2352 by 1568 pixels.
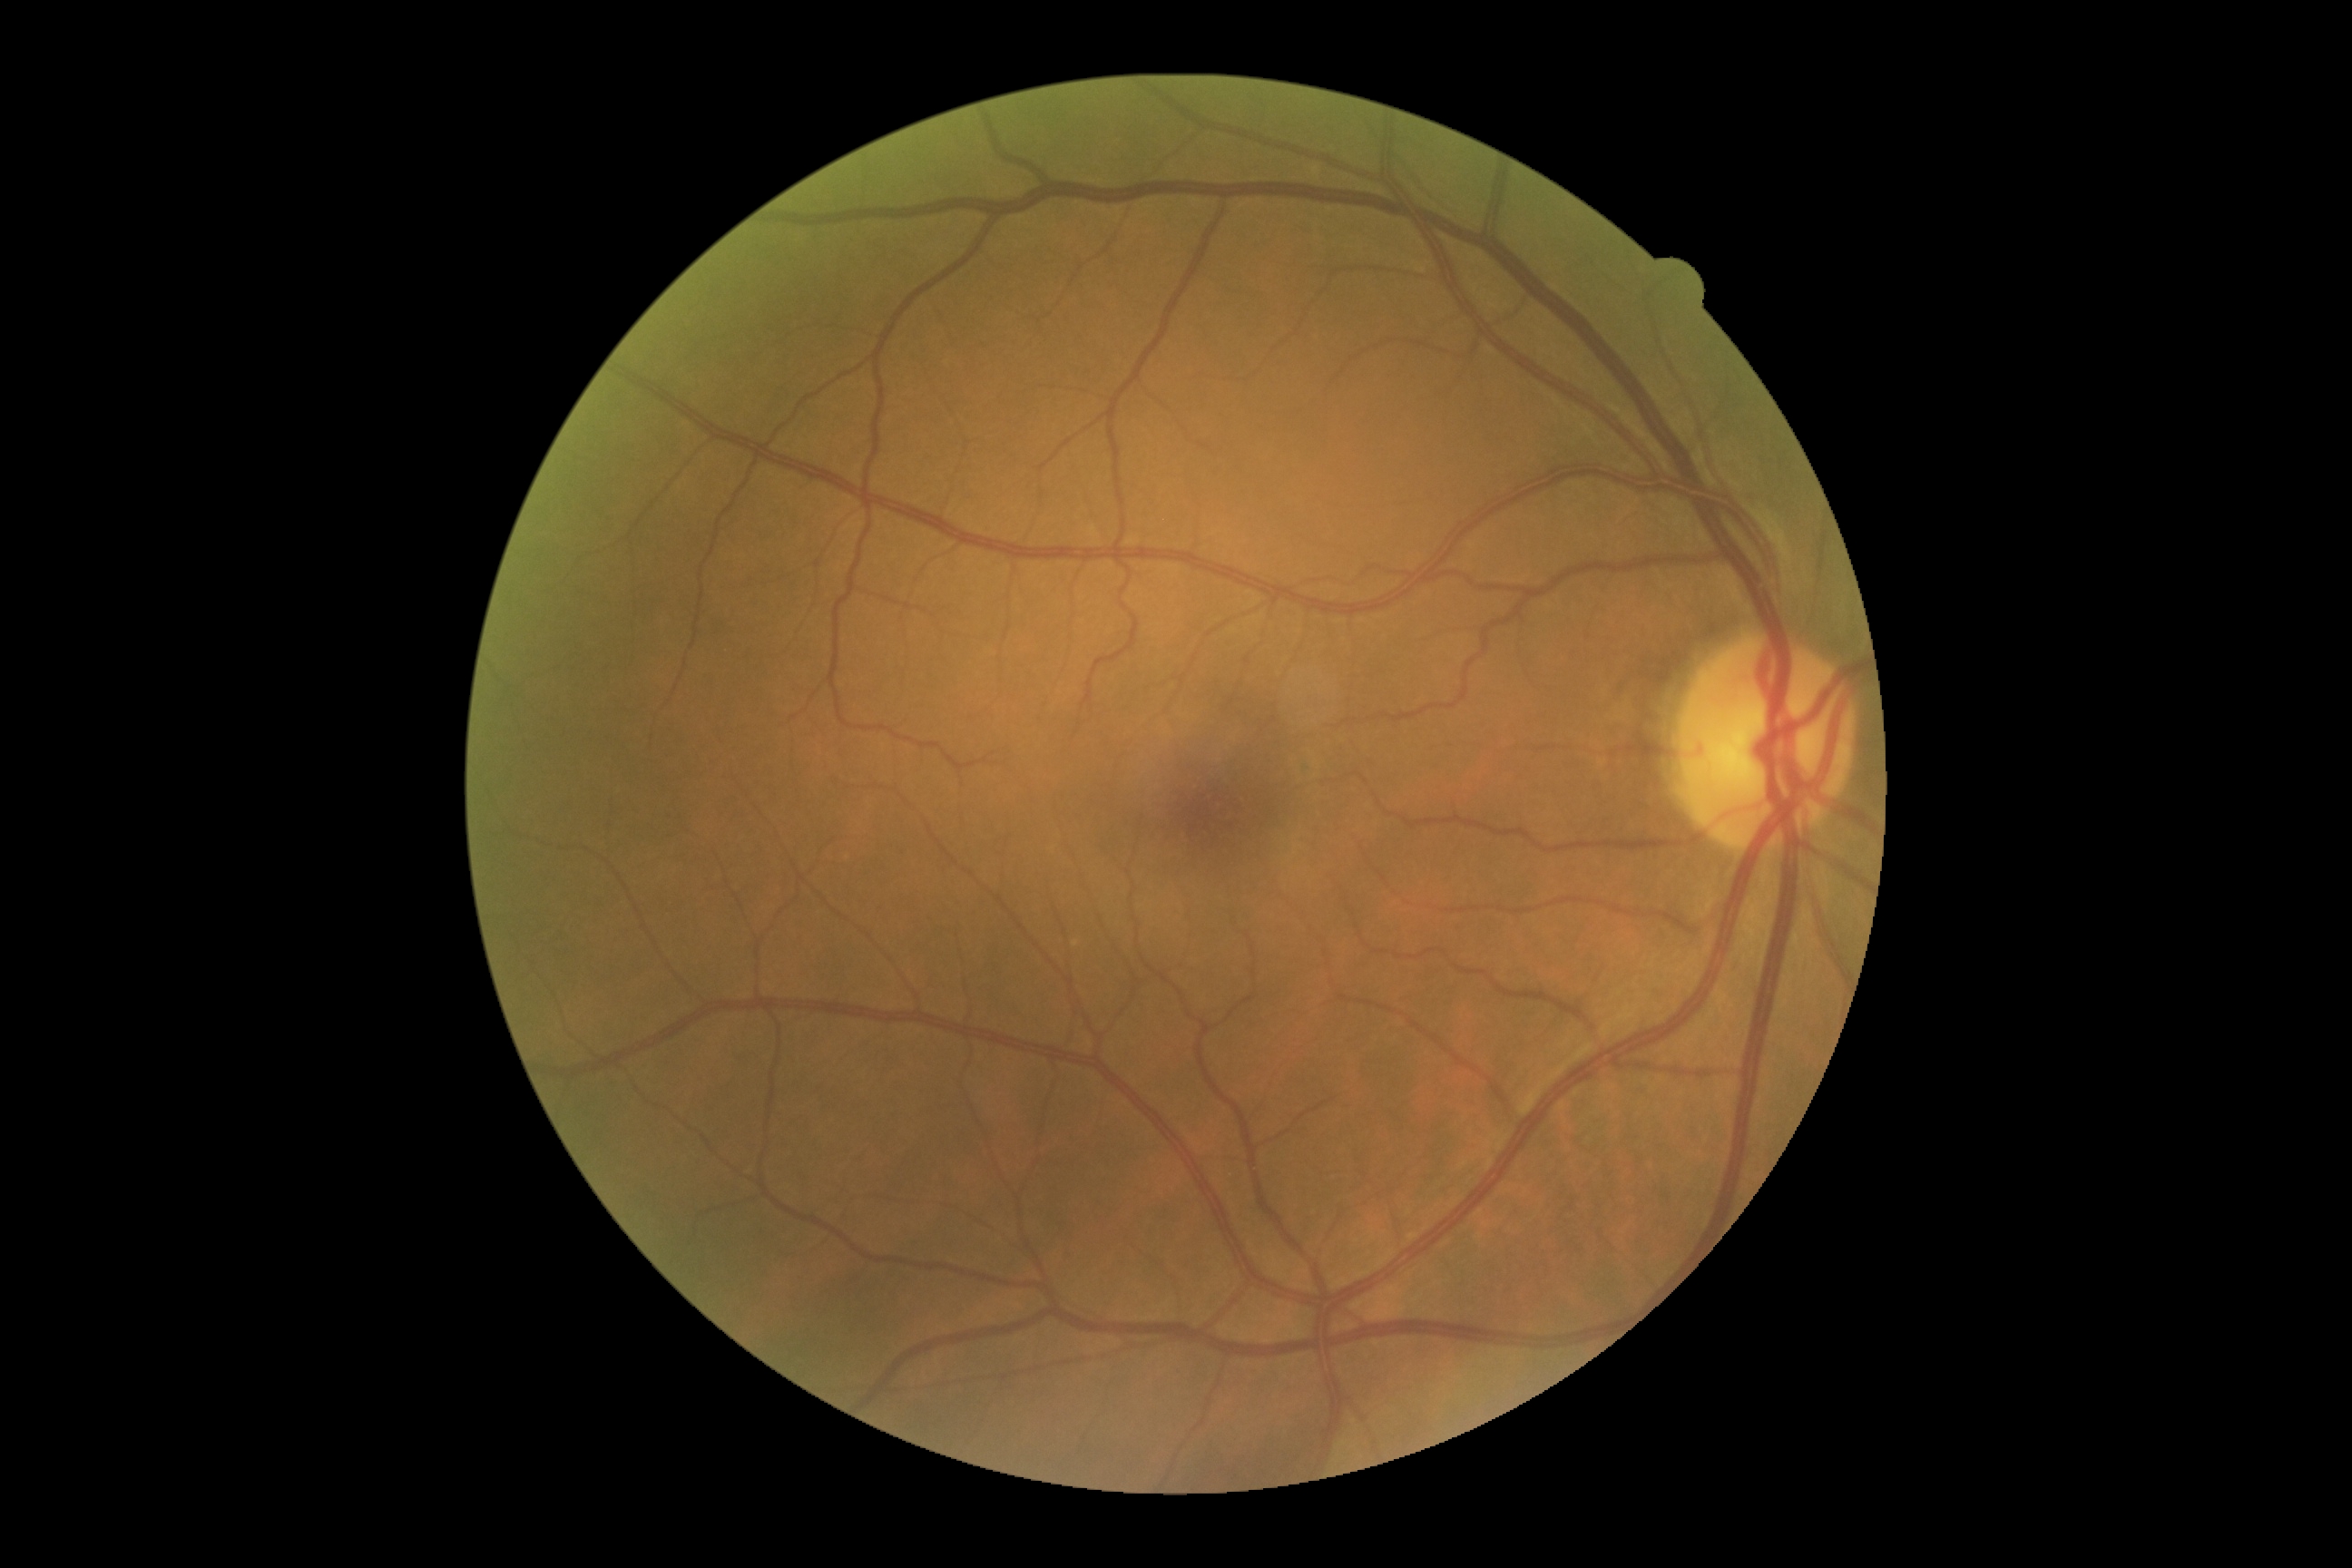 DR grade is 0 (no apparent retinopathy).